Image size 2352x1568.
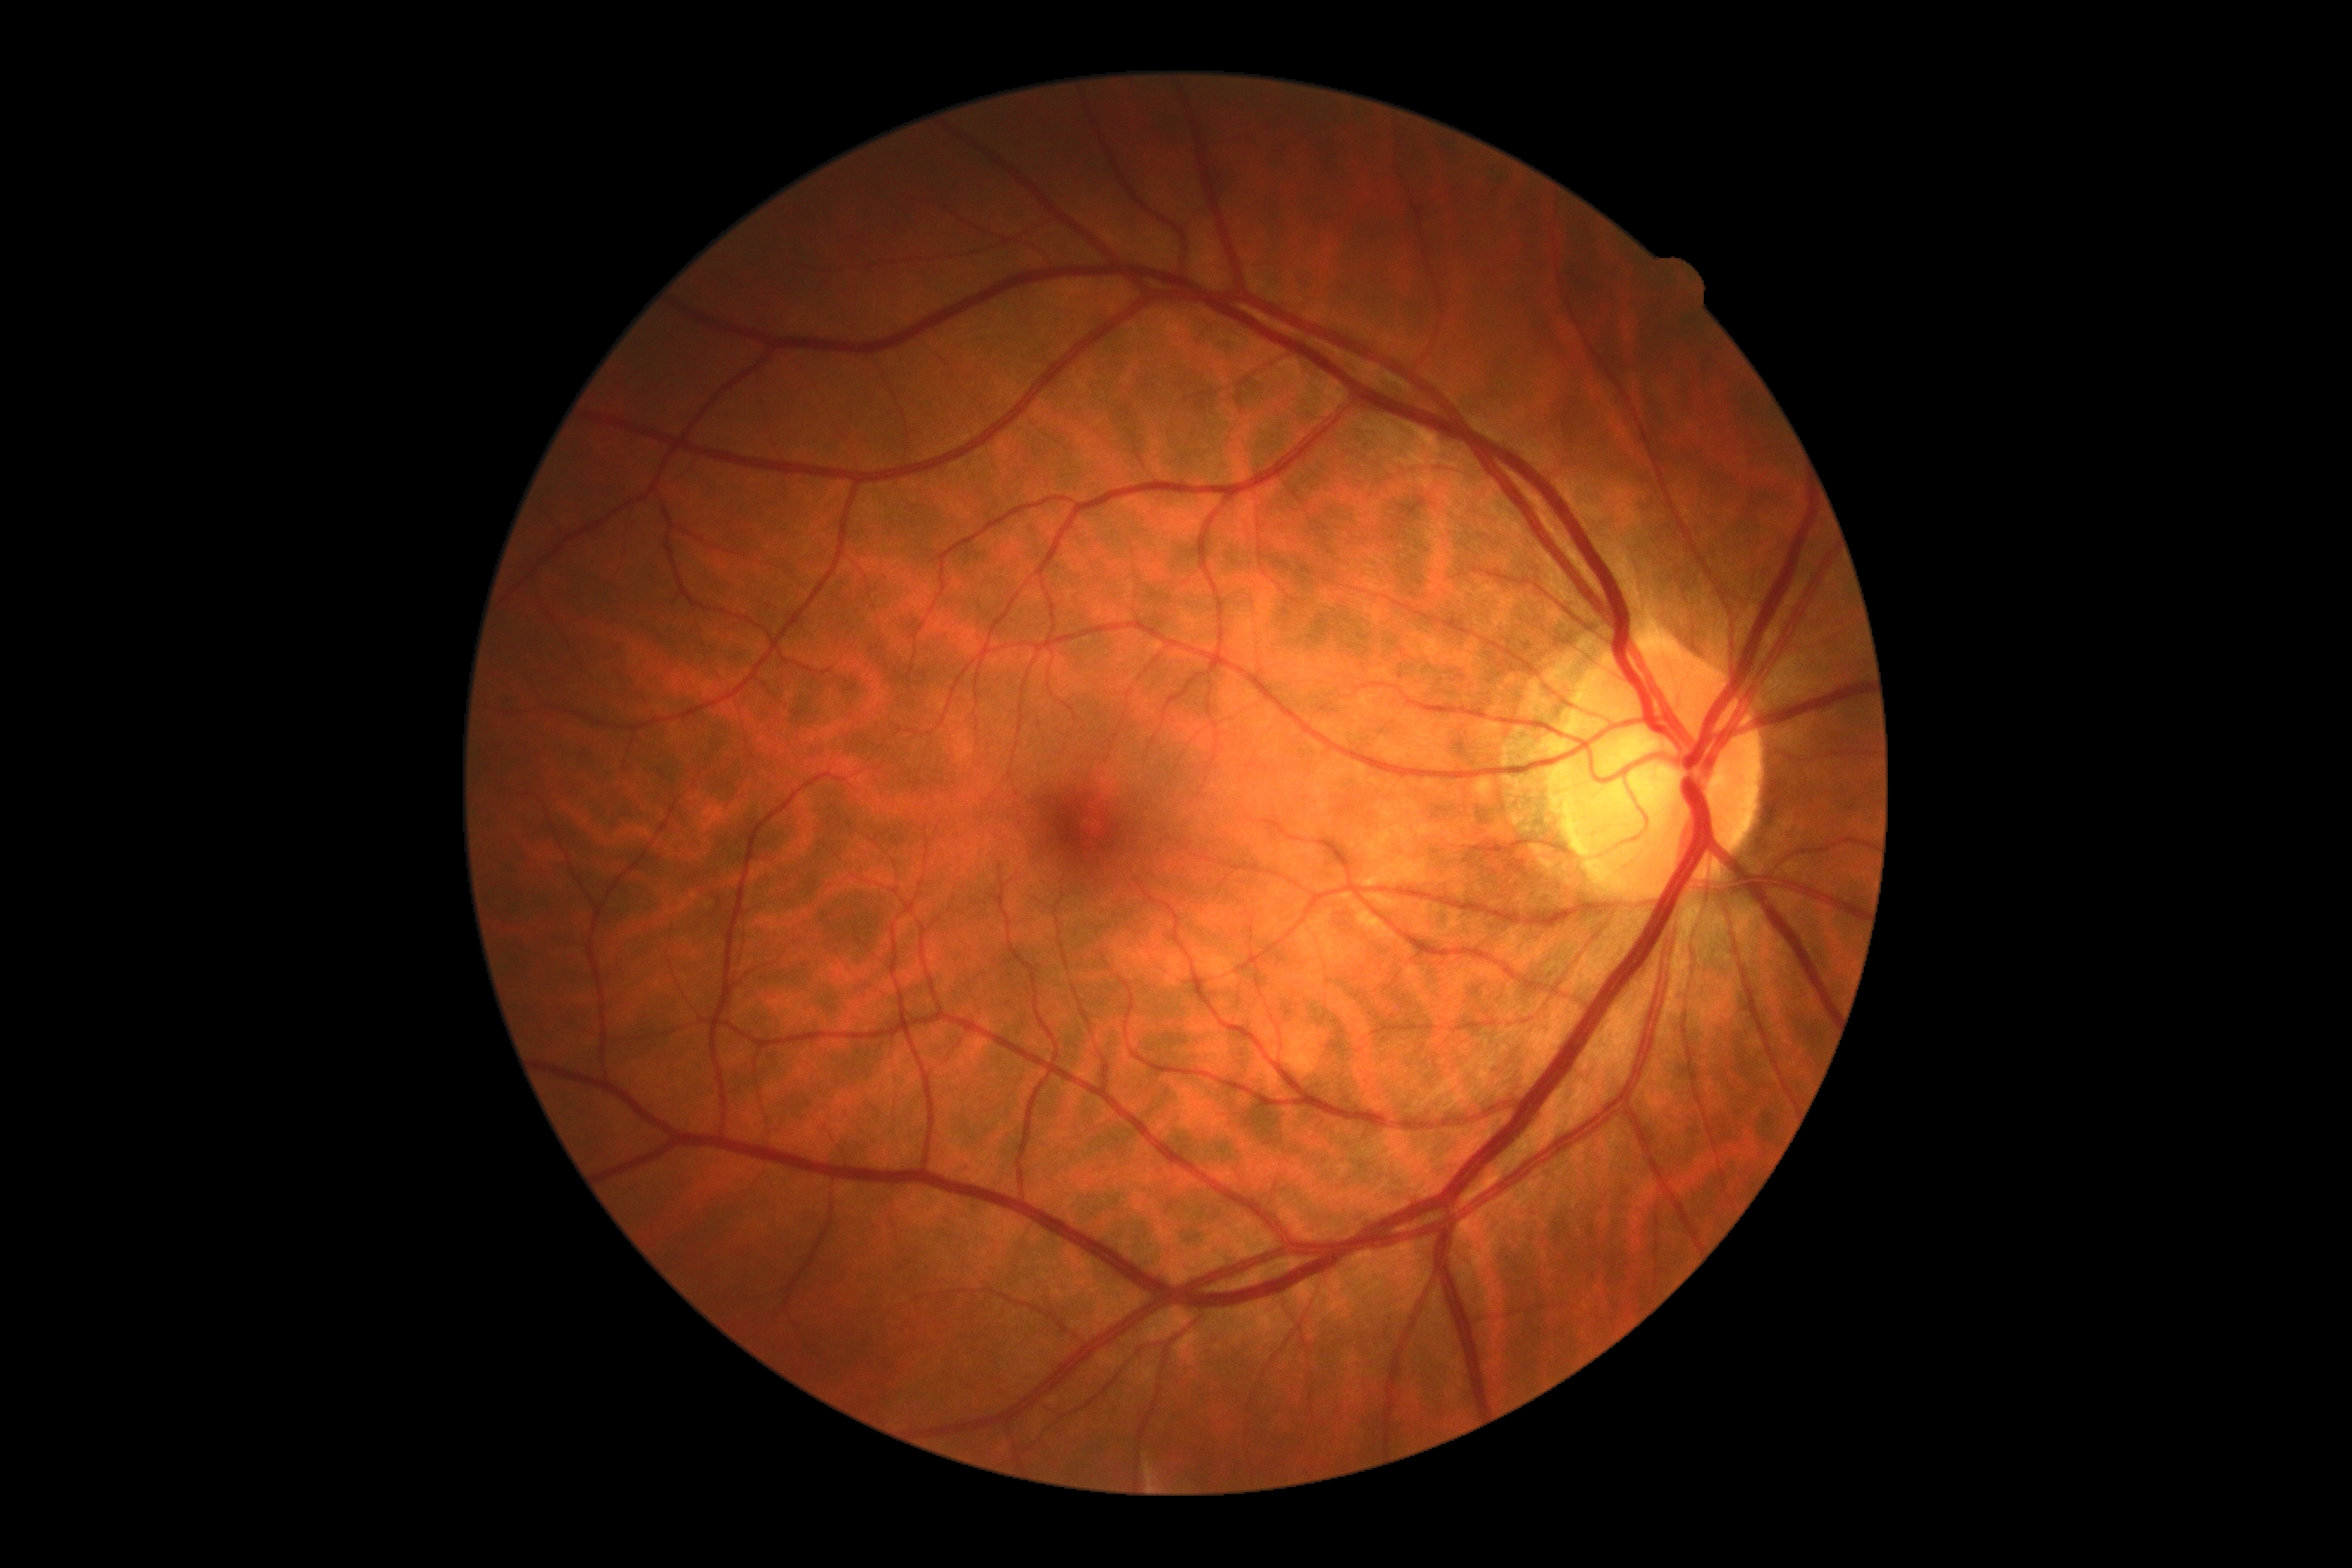
Diabetic retinopathy grade: 0/4.
No DR findings.